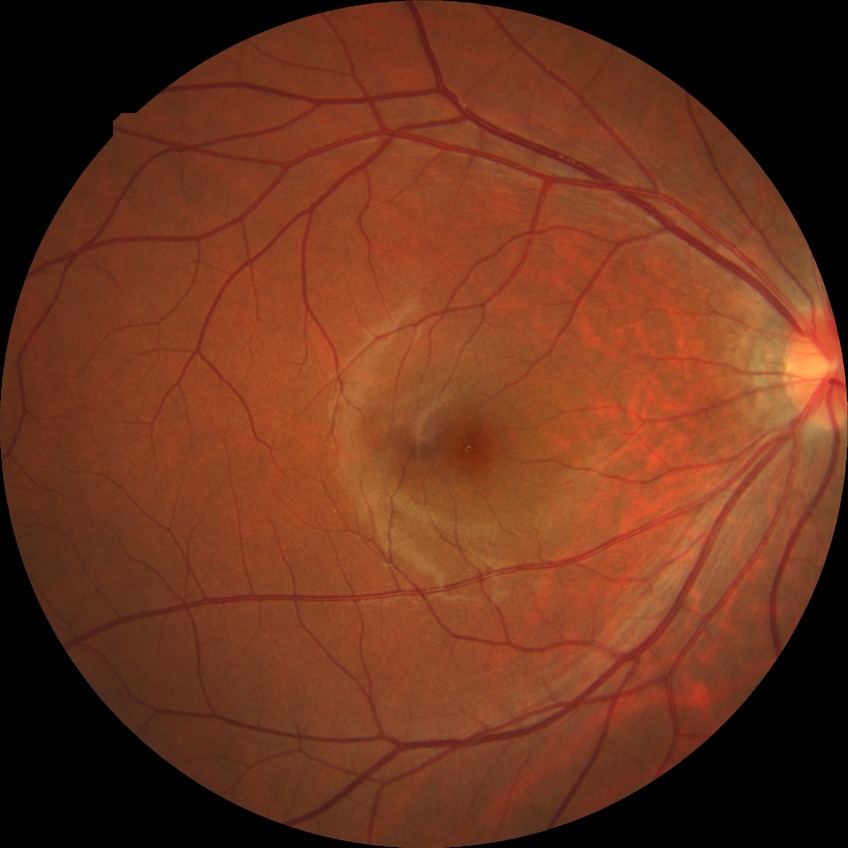 diabetic retinopathy (DR) = NDR (no diabetic retinopathy).